Infant wide-field fundus photograph. Image size 640x480
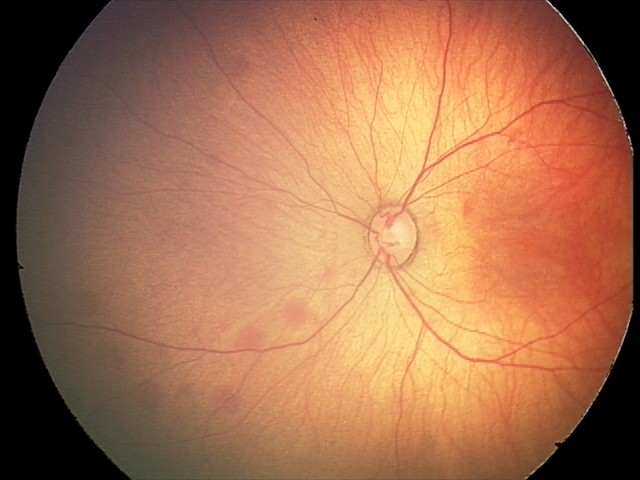

Screening diagnosis = retinal hemorrhages